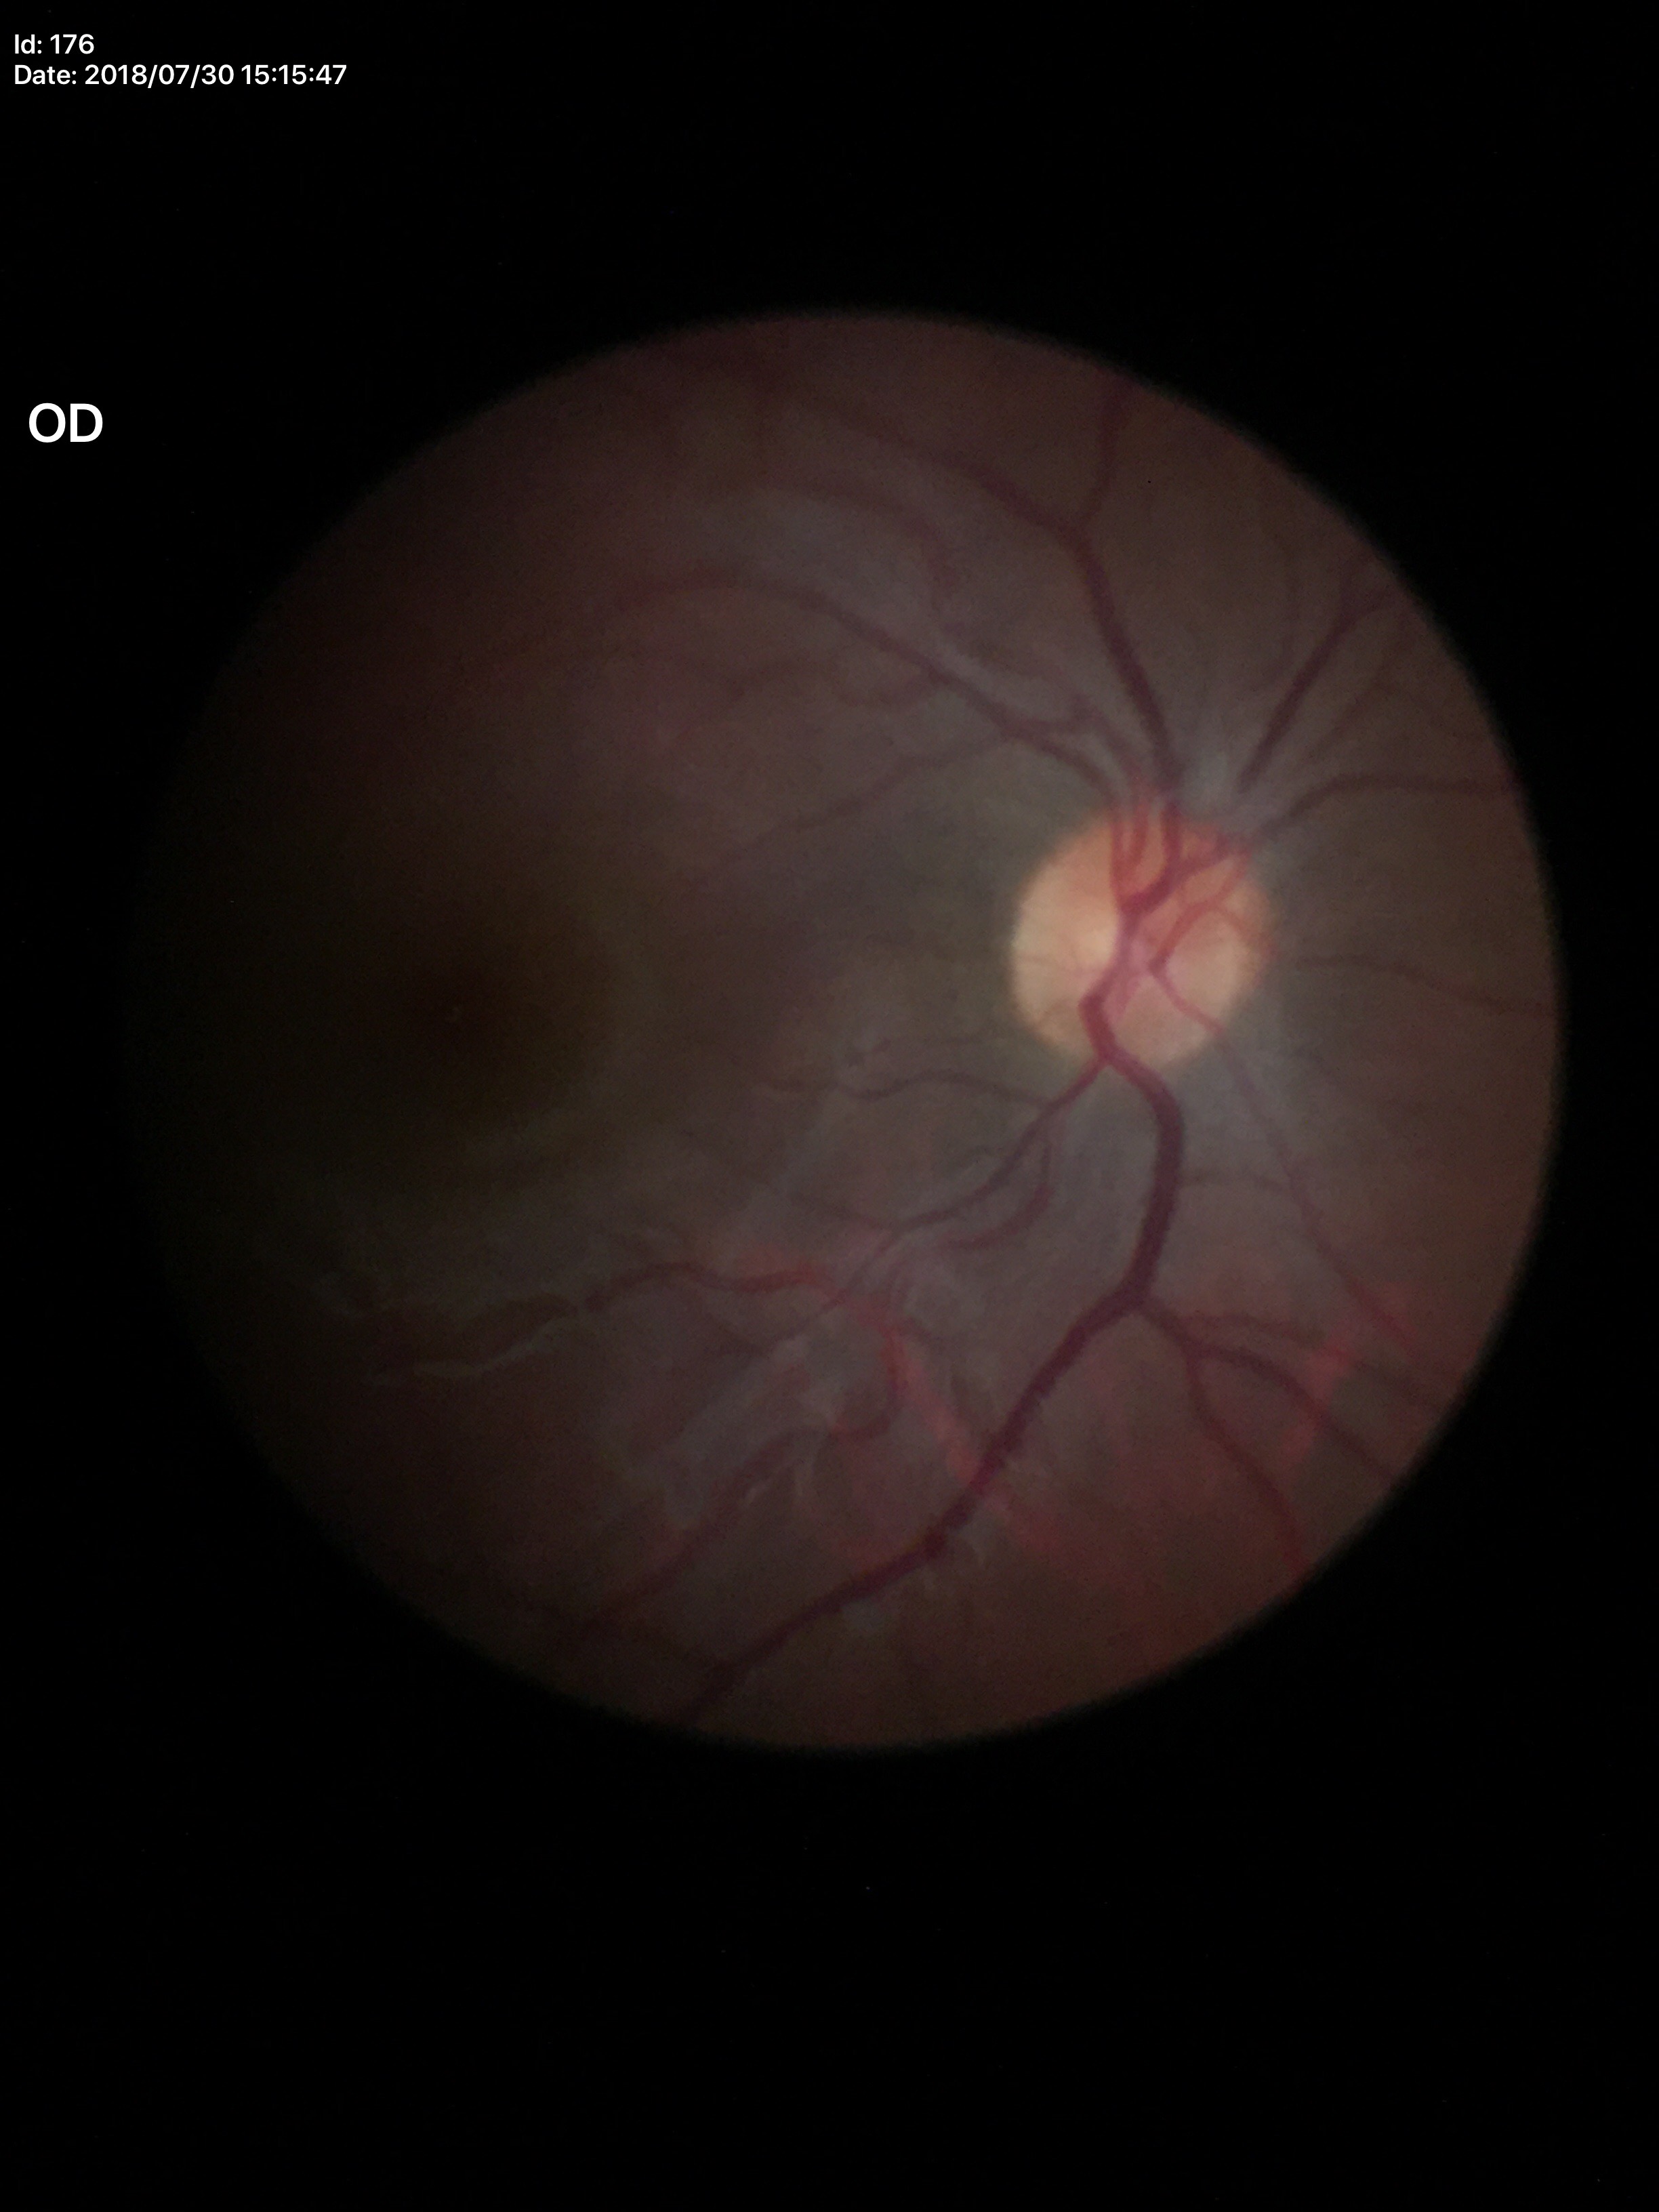

Glaucoma screening impression: no suspicious findings | vertical C/D ratio: 0.50 | horizontal CDR: 0.47.